848x848px.
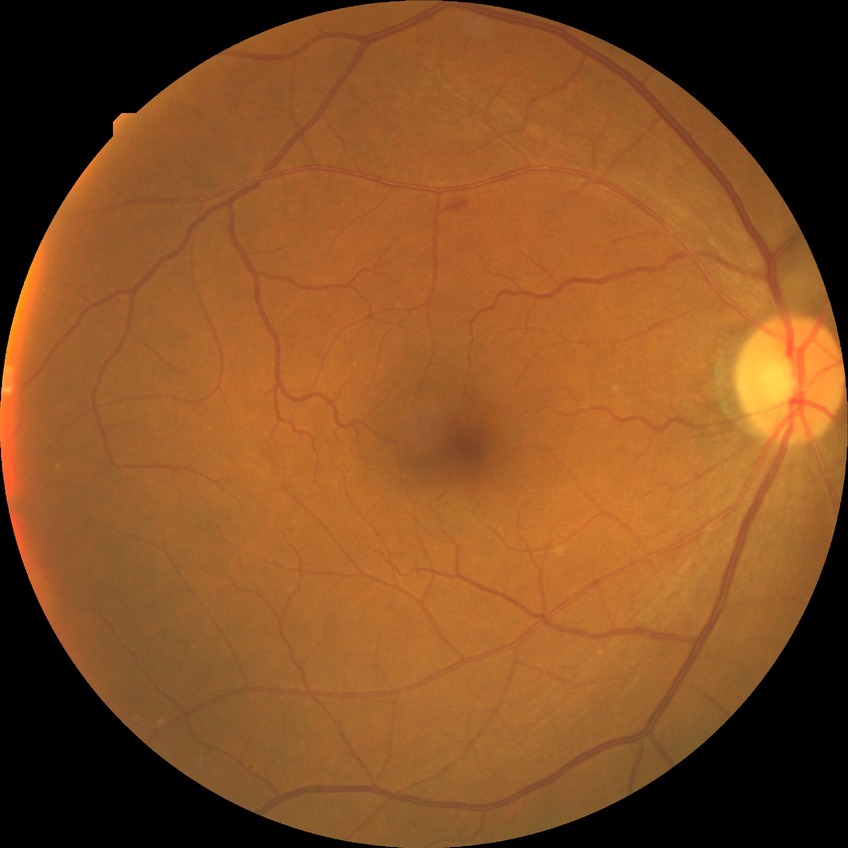

DR class: non-proliferative diabetic retinopathy. DR grade is SDR.